Acquired with a Topcon TRC-NW8: 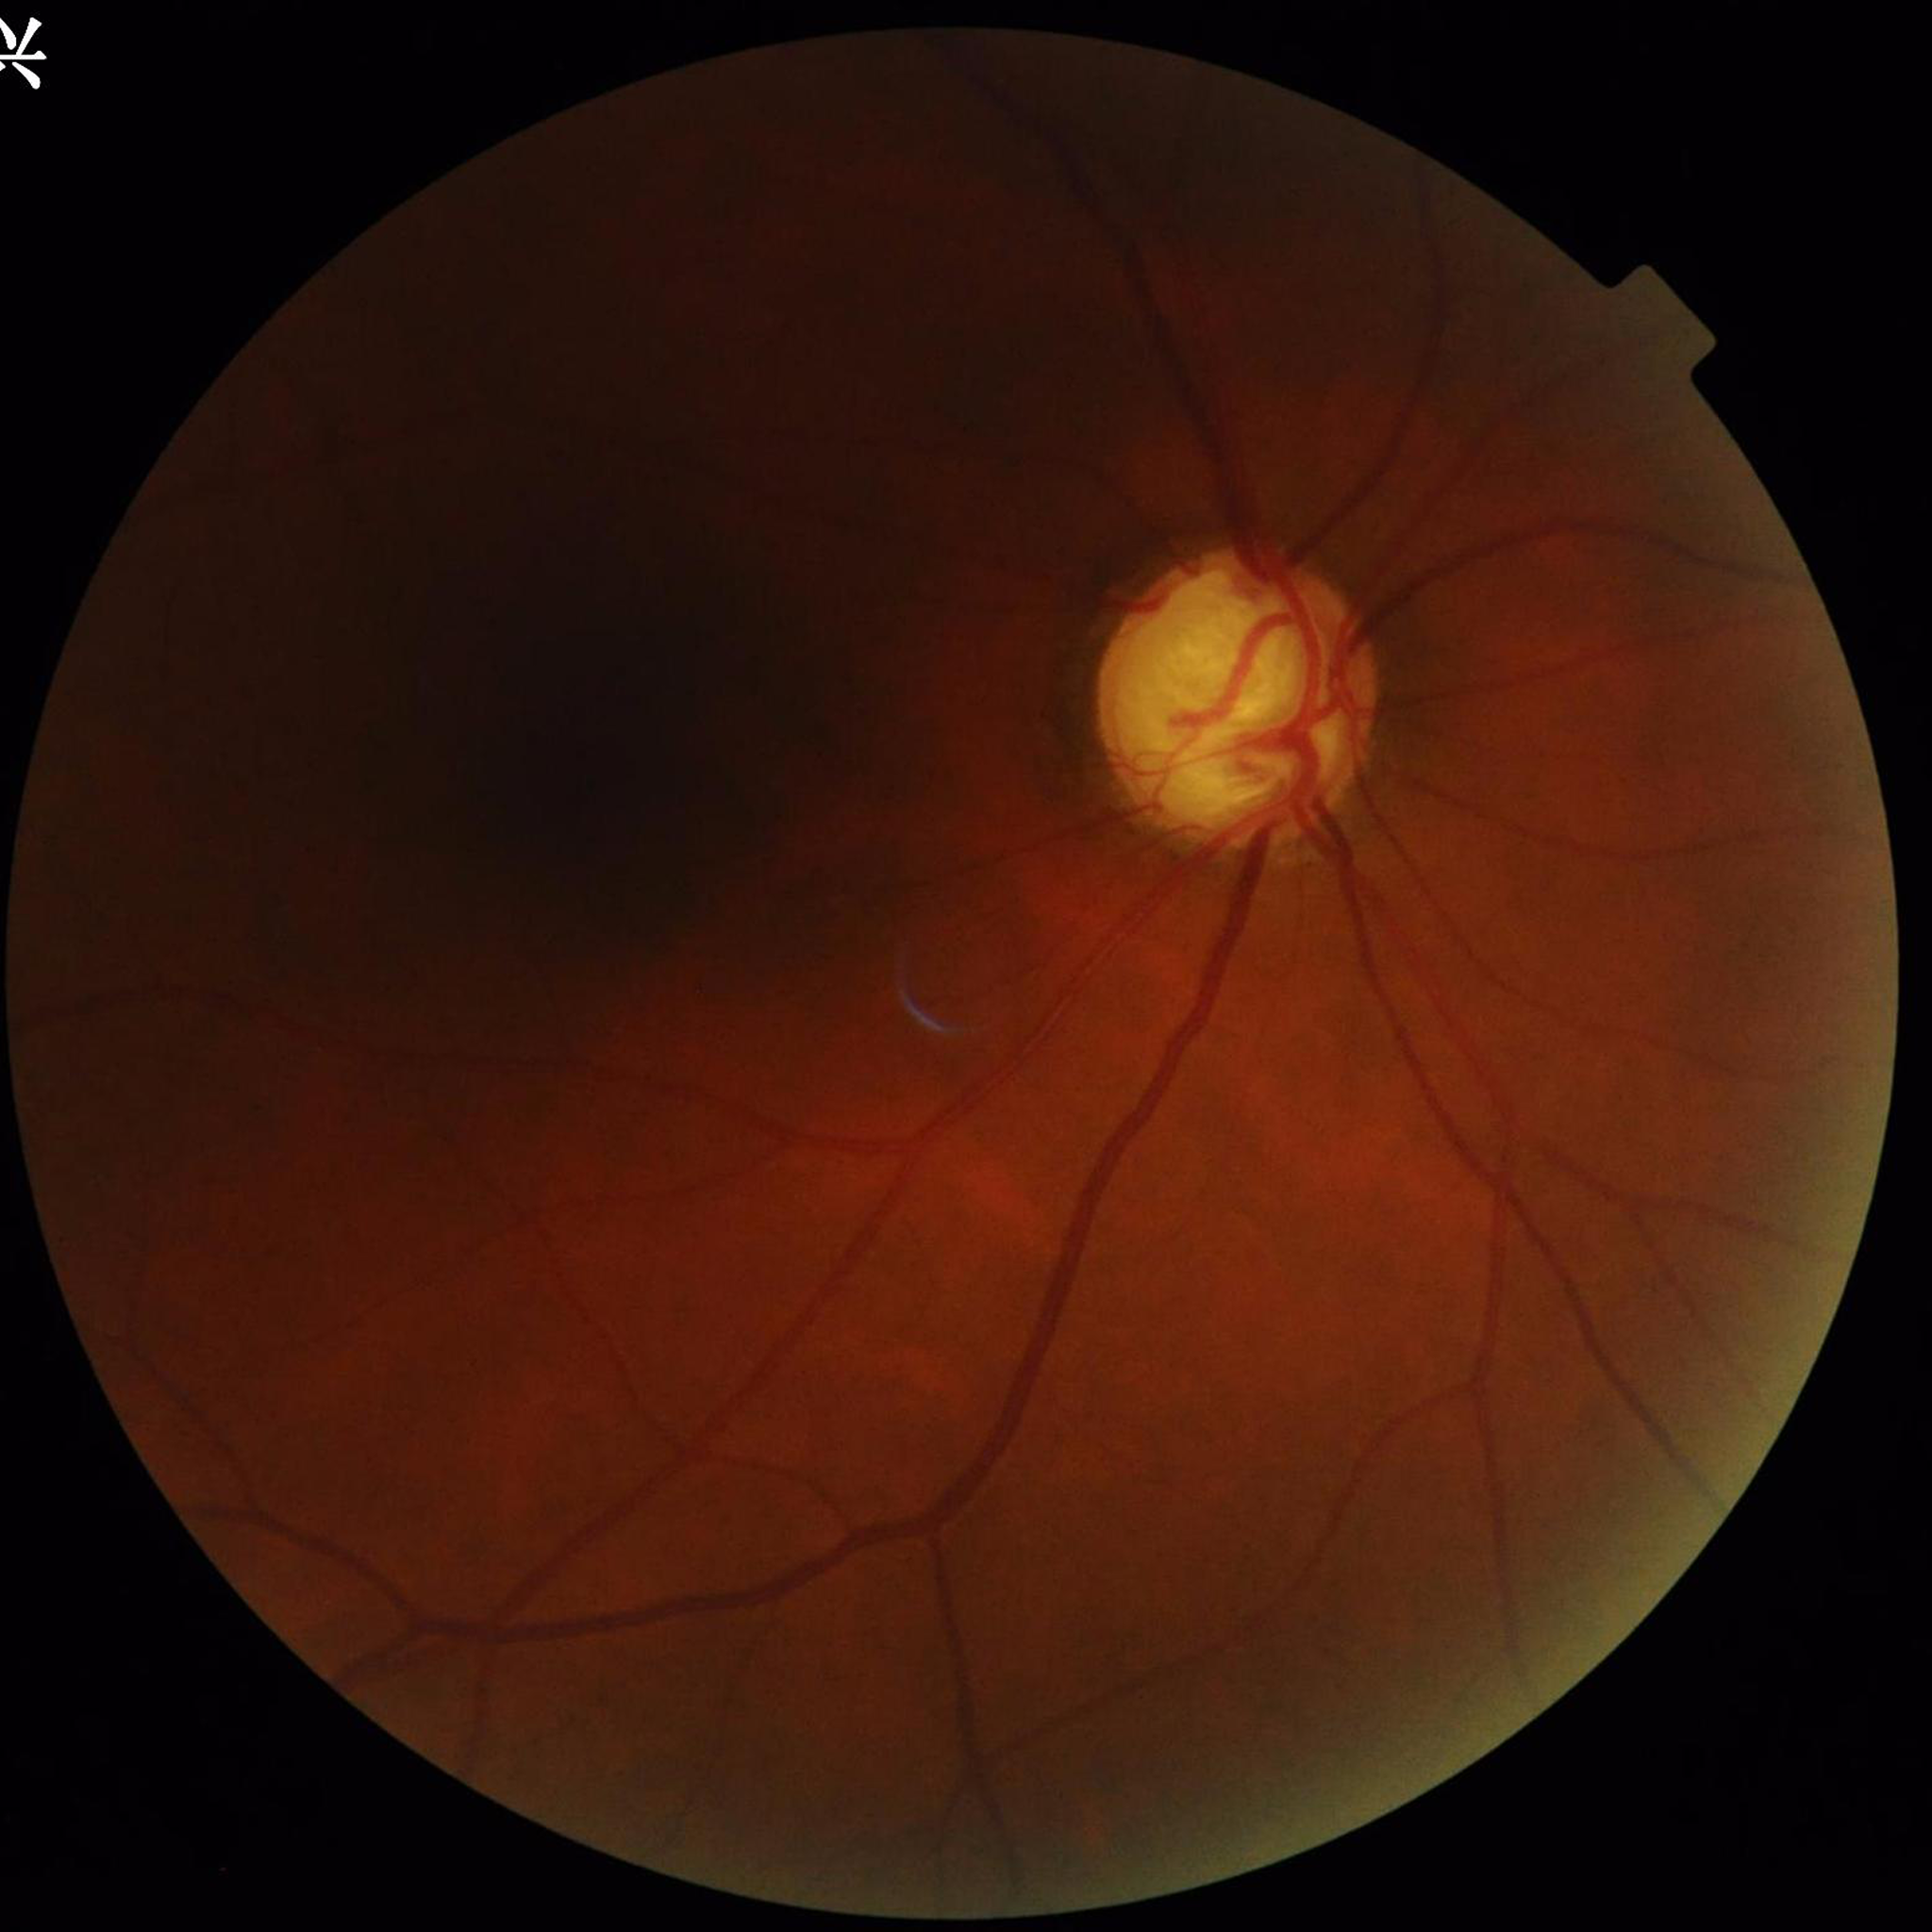 Condition: glaucoma; Quality assessment: concerns include illumination/color distortion.